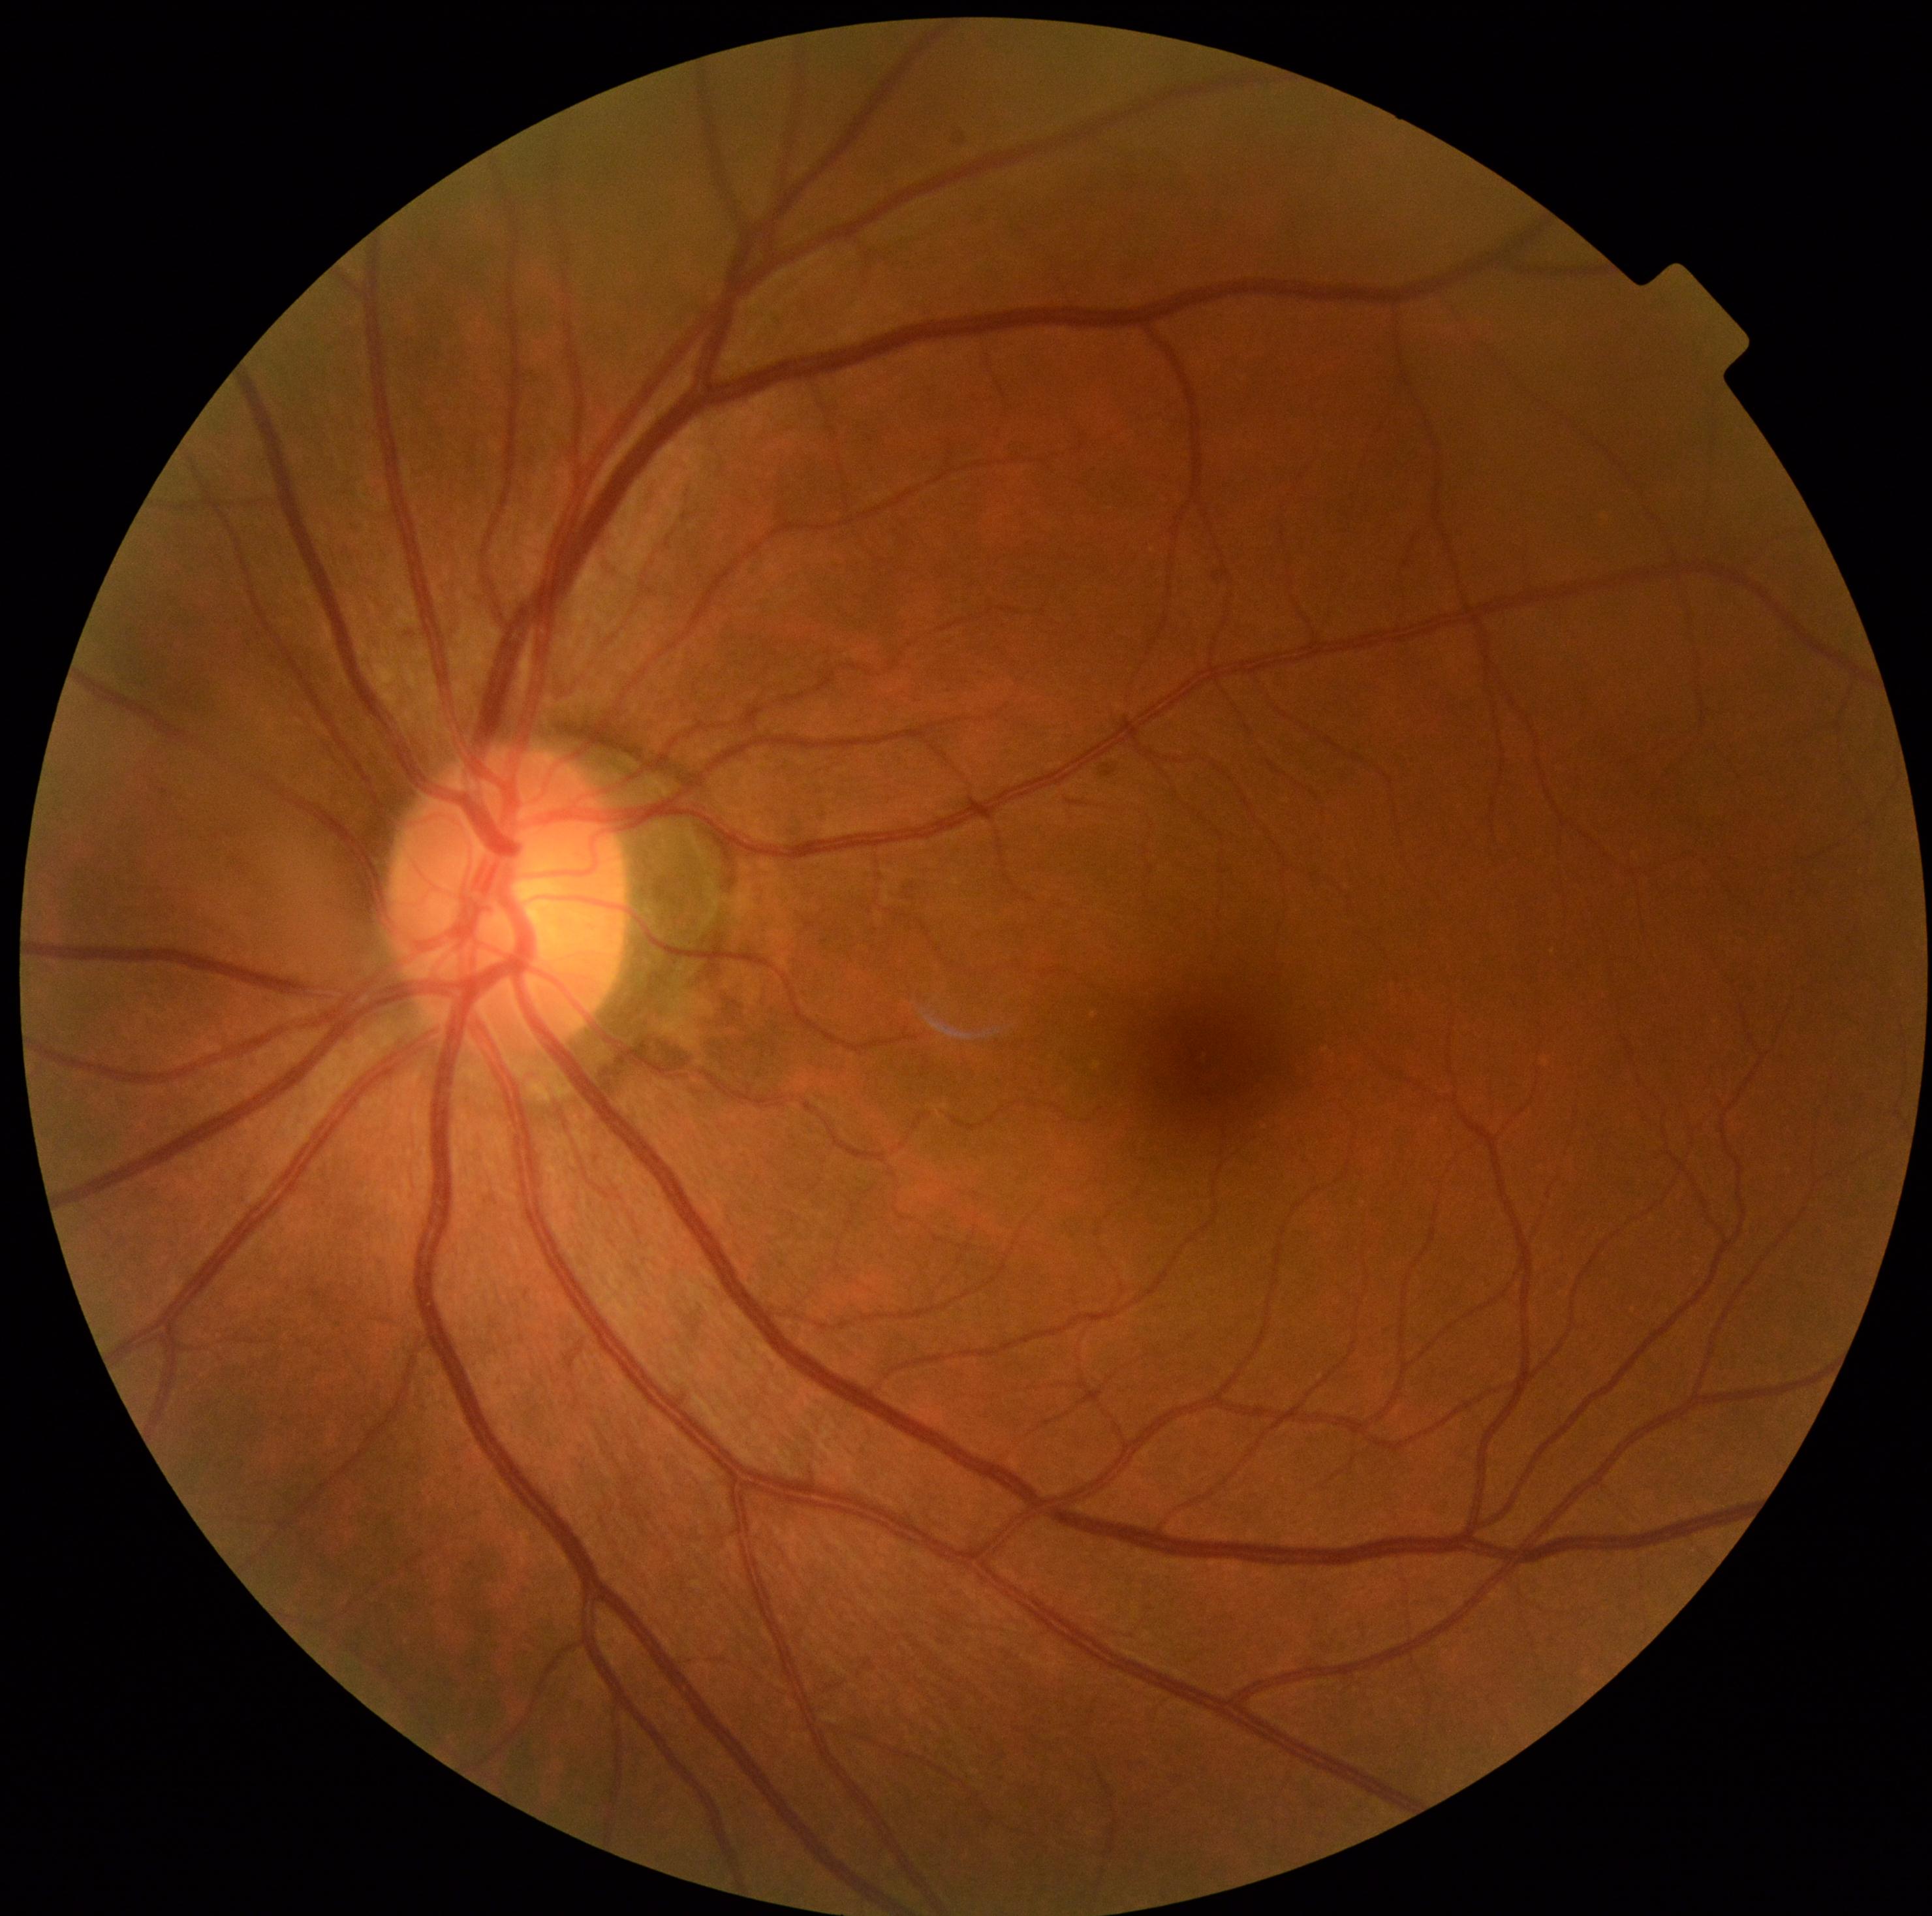

DR stage = grade 0 (no apparent retinopathy).